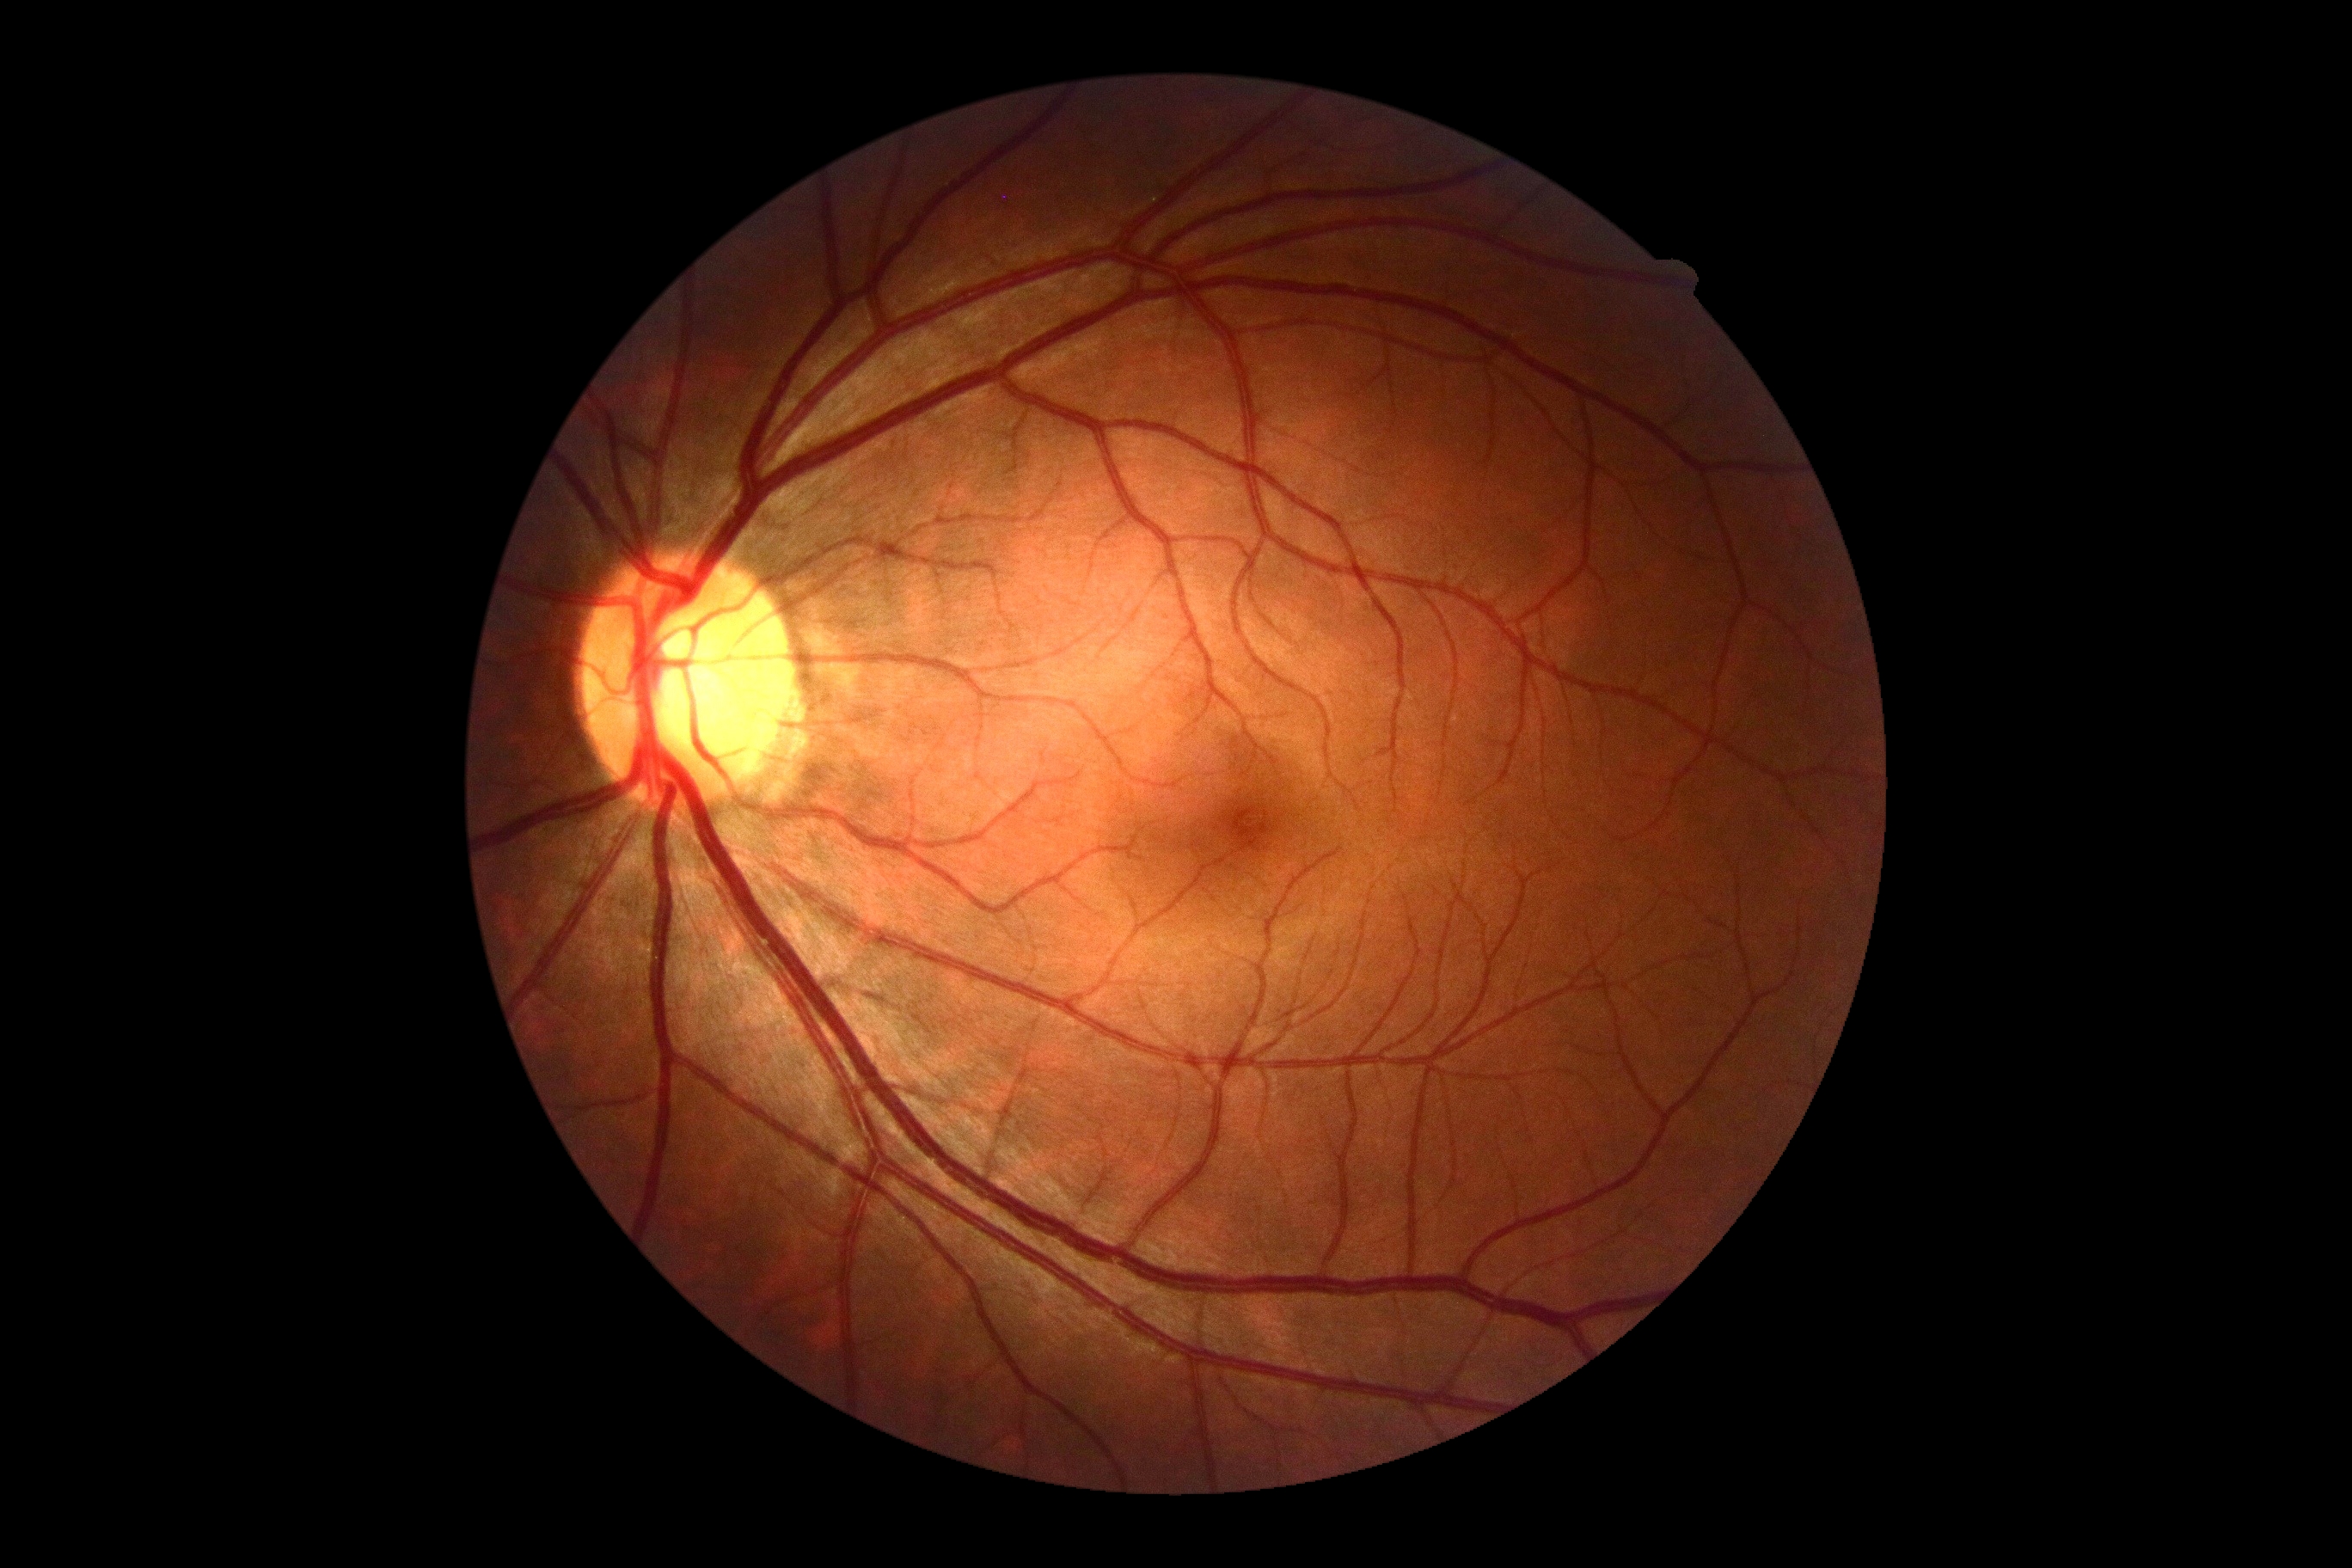 retinopathy = no apparent retinopathy (grade 0)
DR impression = no DR findings